Image size 1659x2212.
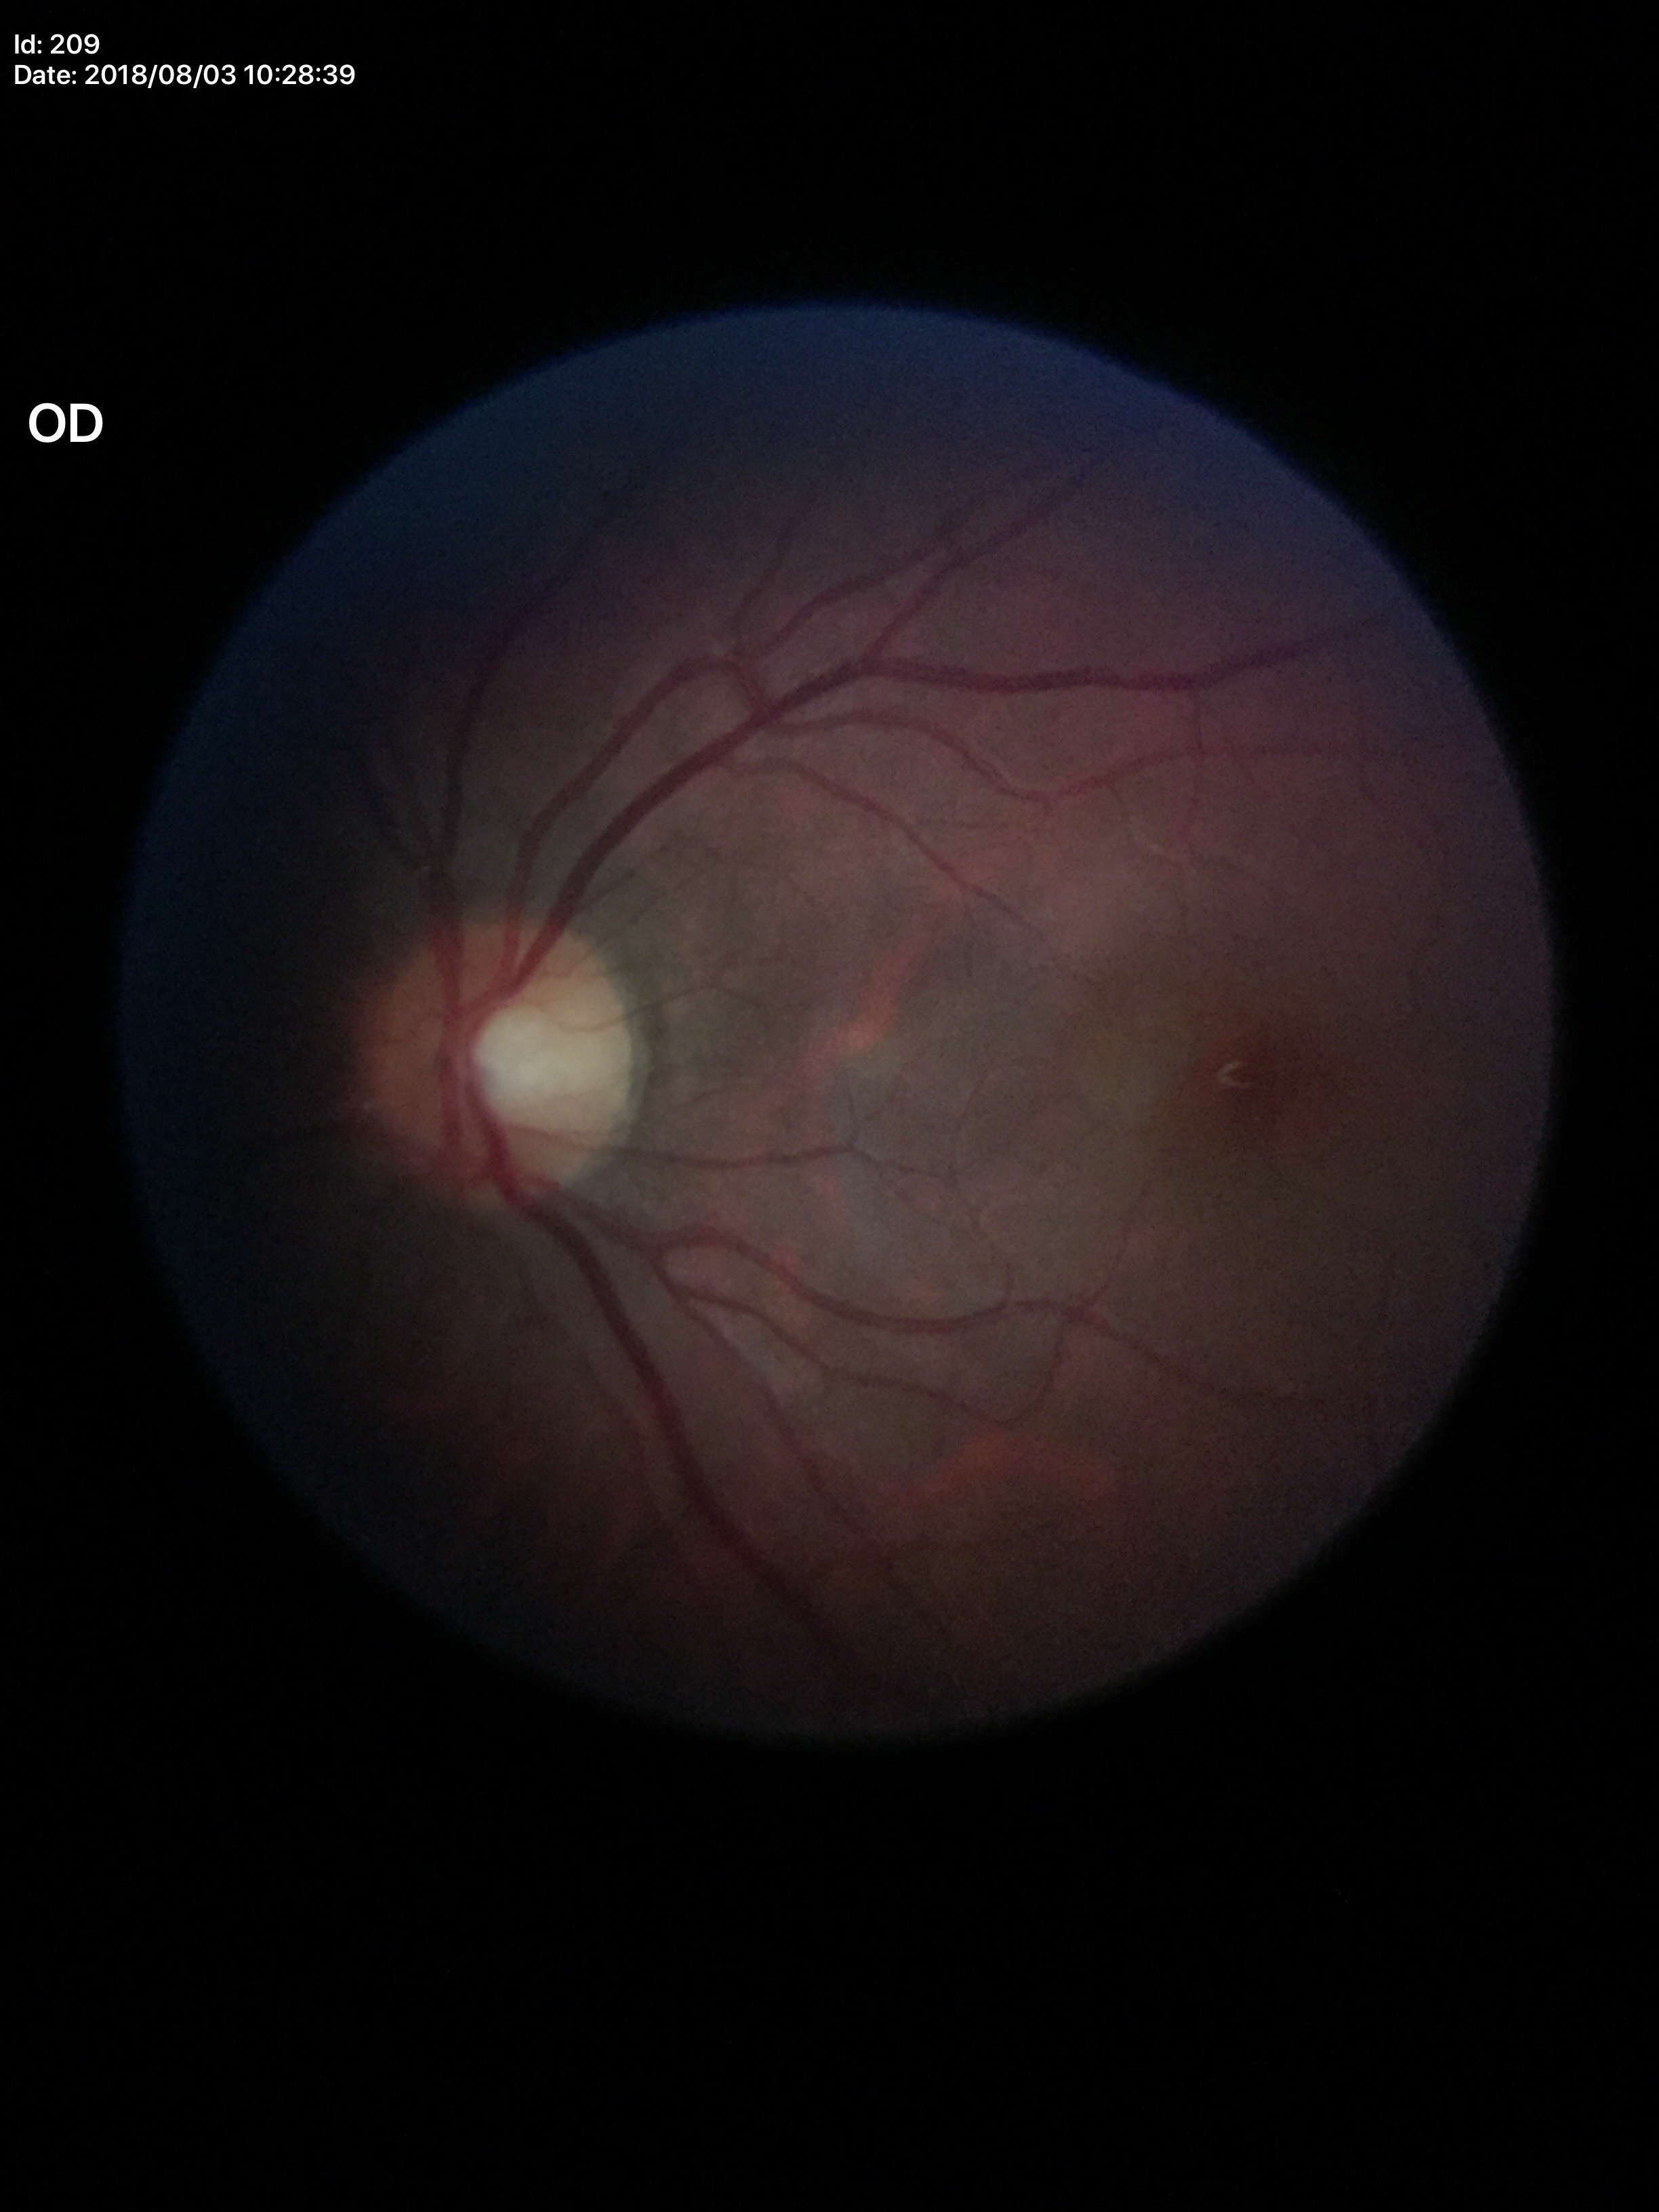

No evidence of glaucoma.
Vertical cup-disc ratio of 0.46.
Horizontal CDR is 0.48.